Image size 1380x1382, 45° field of view
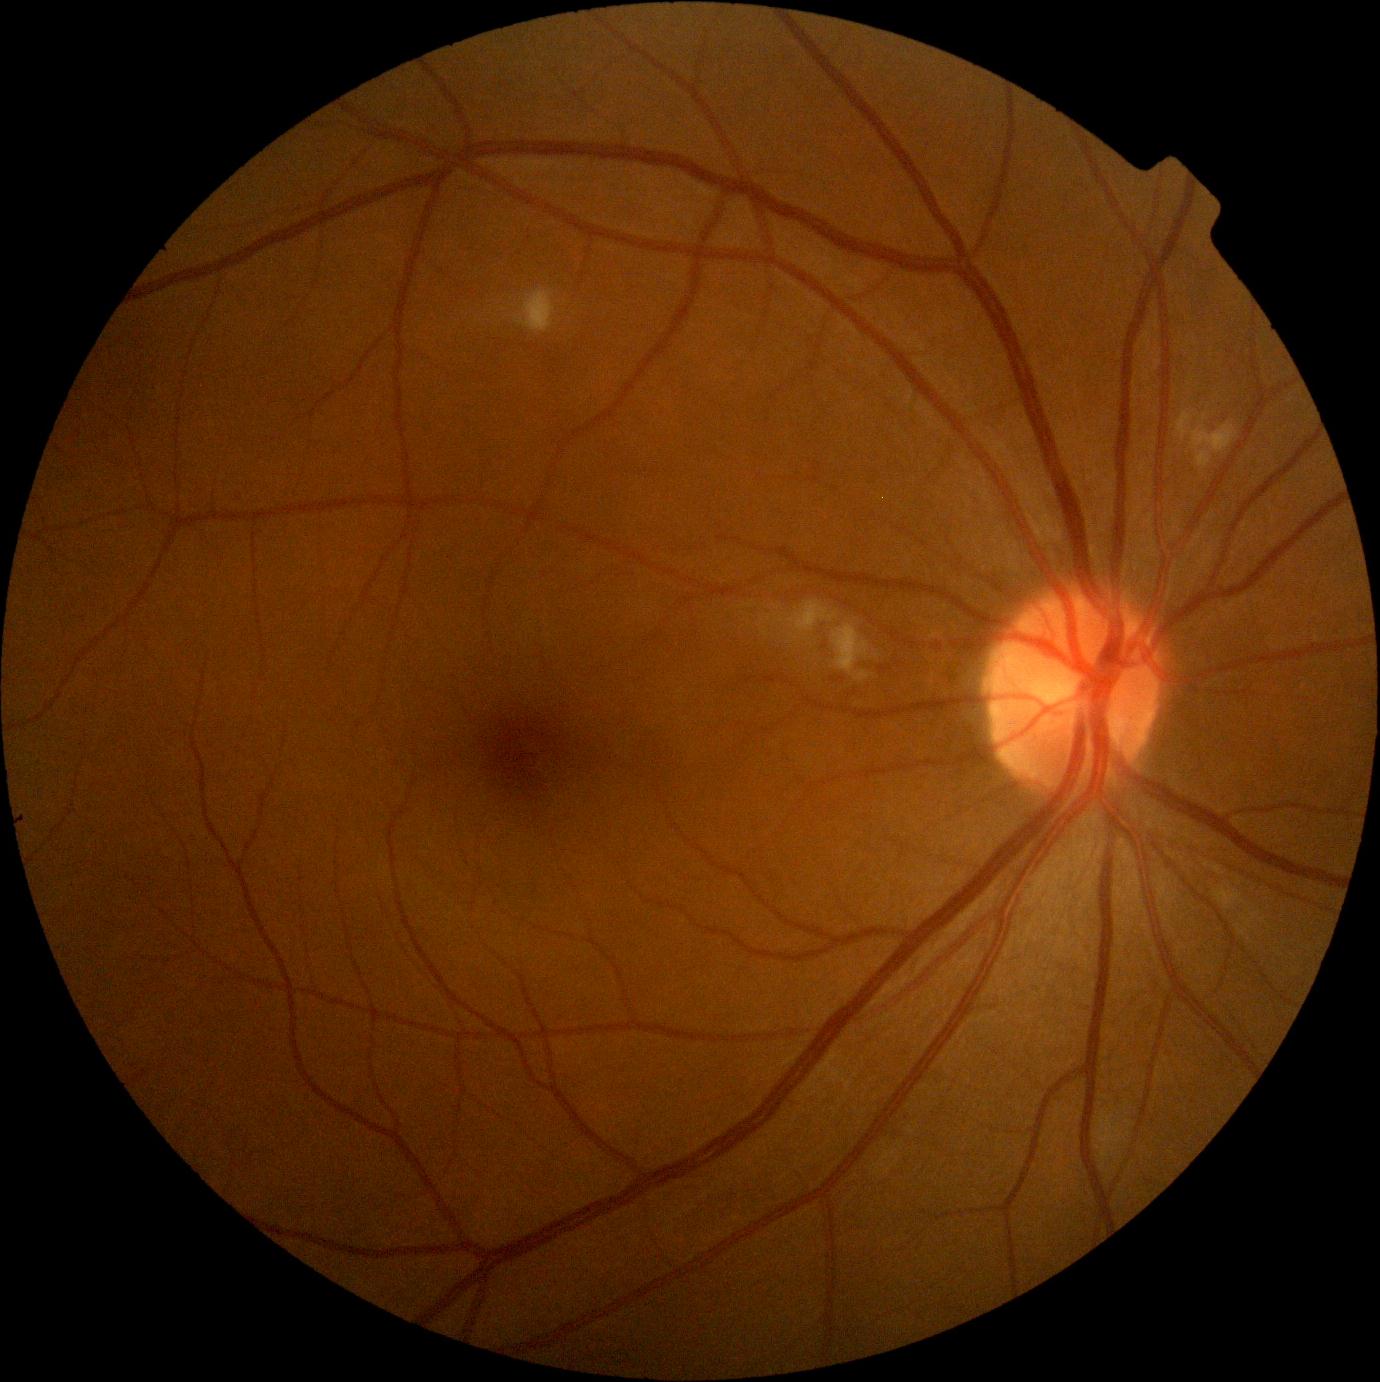 {"dr_grade":2,"dr_grade_name":"moderate NPDR","lesions":{"he":null,"ma":null,"ex":null,"se":[[515,289,556,333],[1178,413,1239,470],[789,601,839,635],[832,624,871,682]]}}